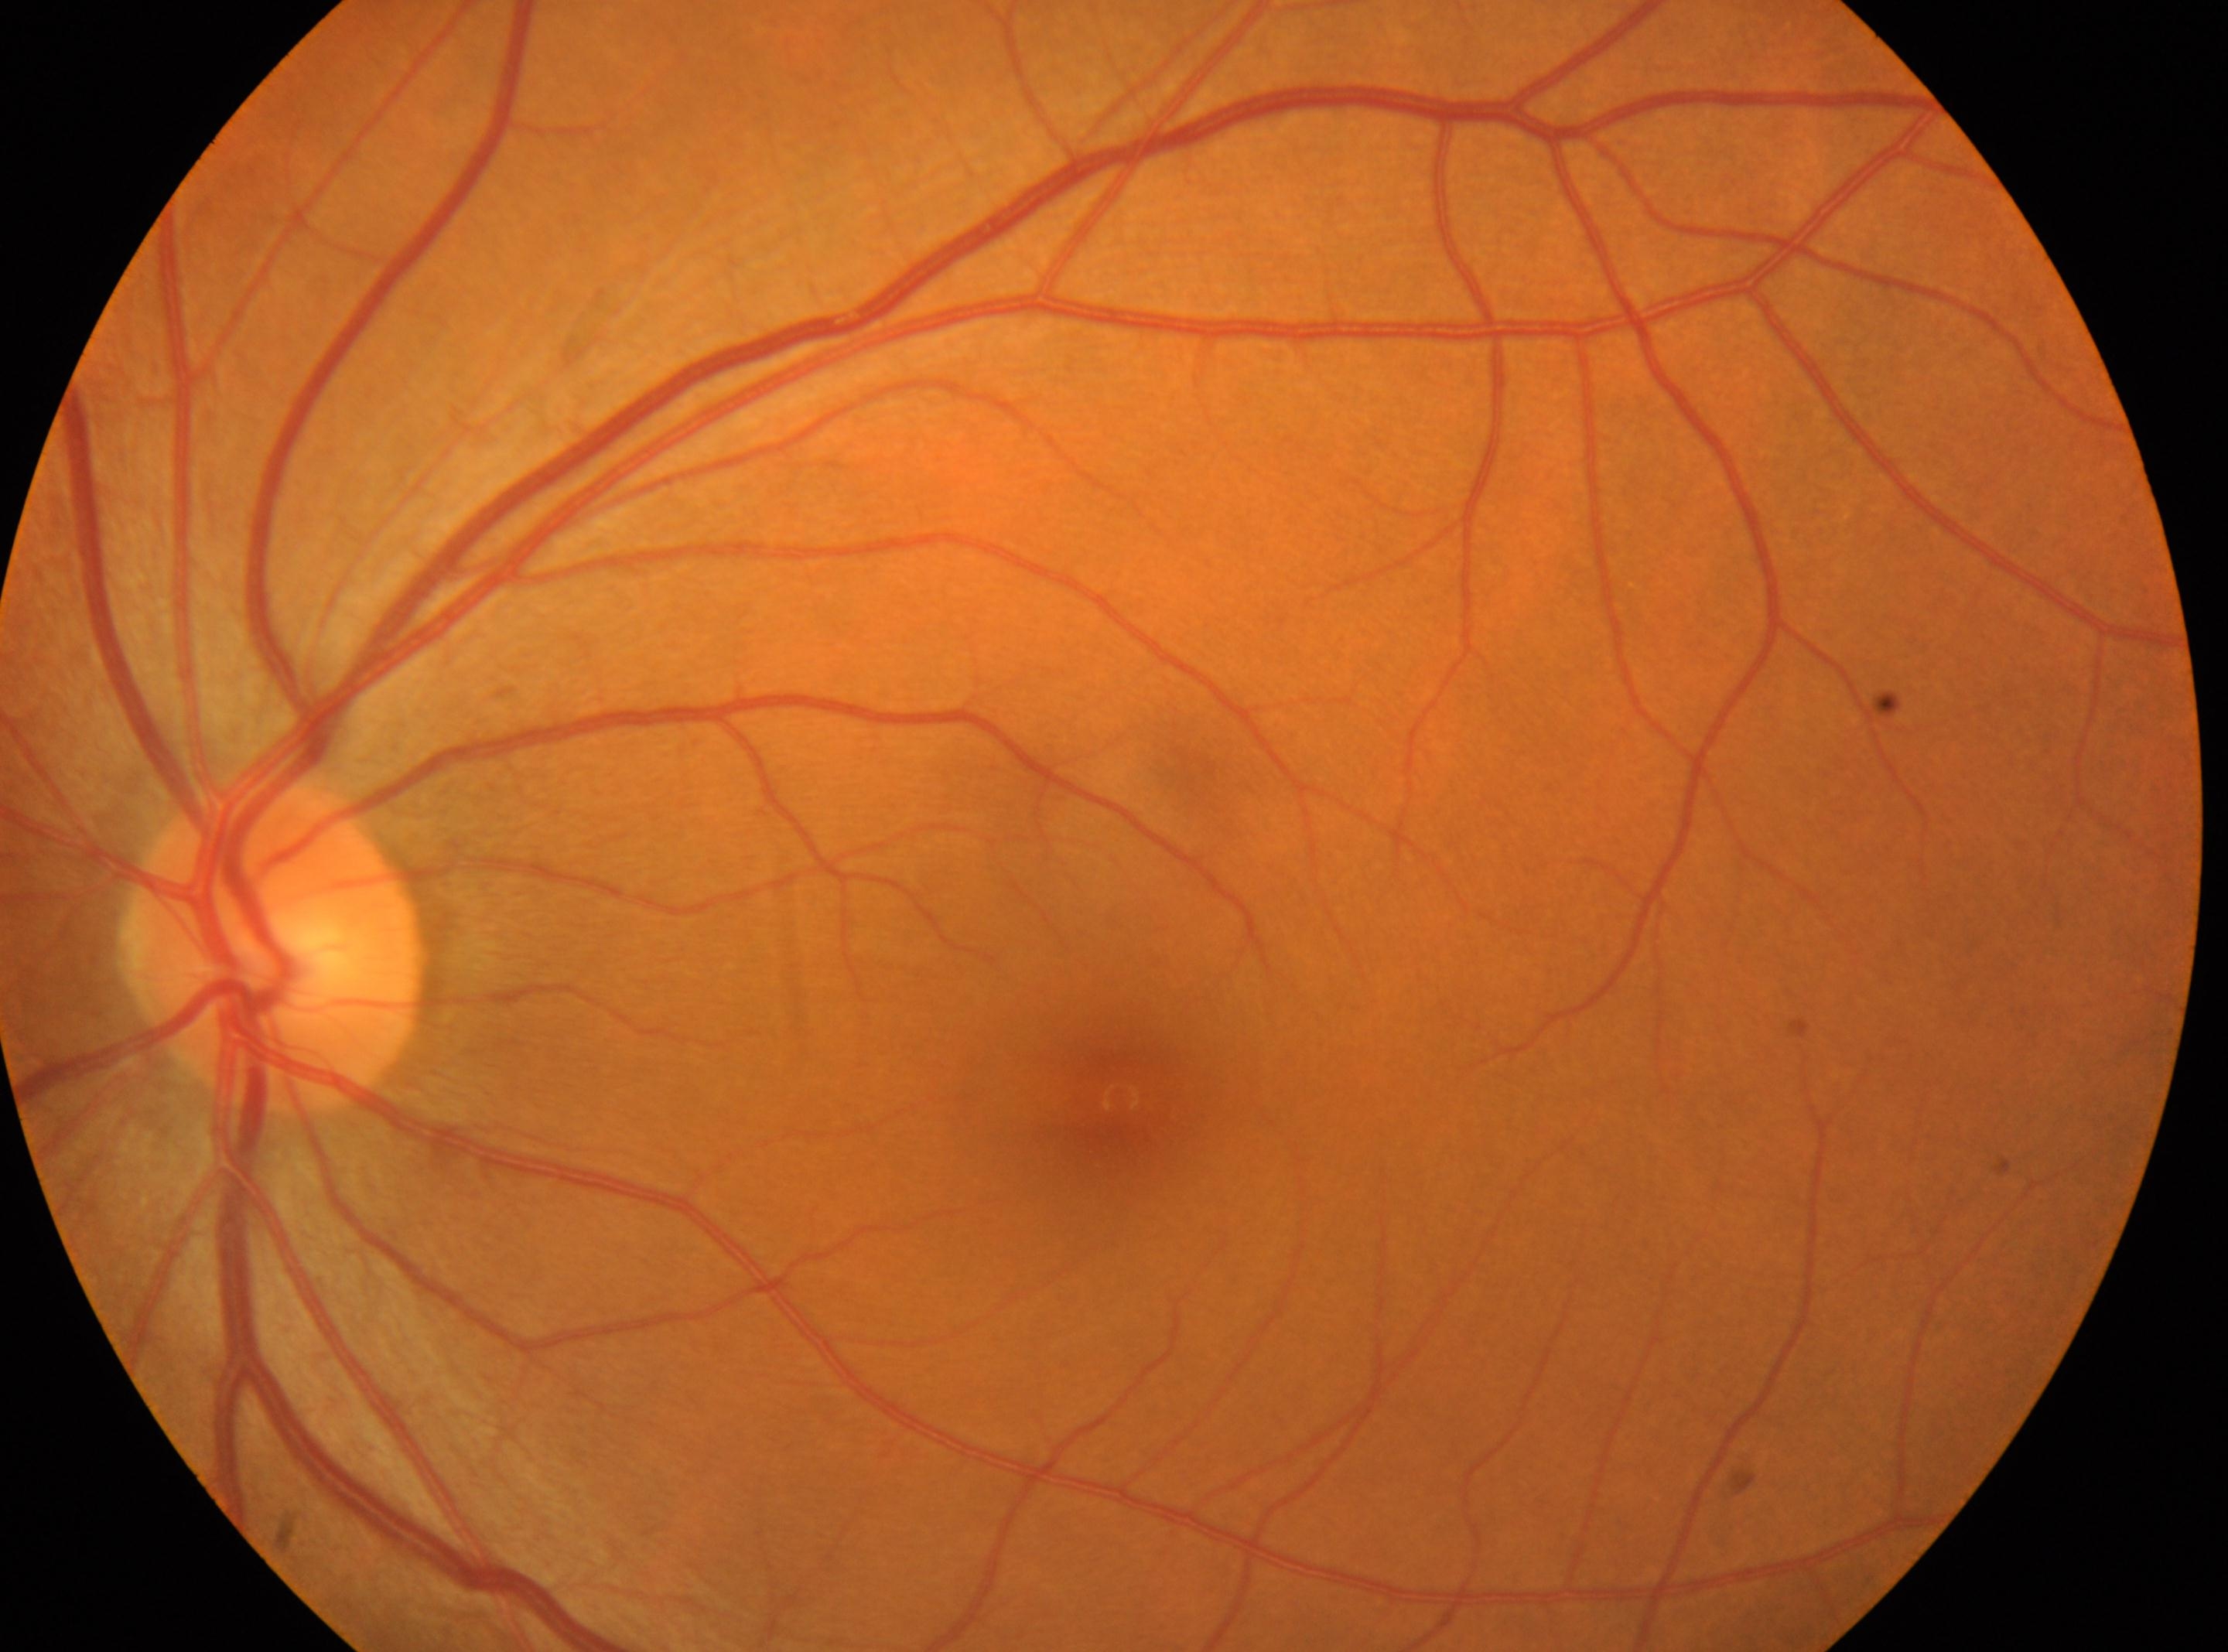
DR stage: 0.
The optic disc is at (x=275, y=945).
This is the oculus sinister.
Fovea center located at (x=1120, y=1097).
No signs of diabetic retinopathy.